45° FOV.
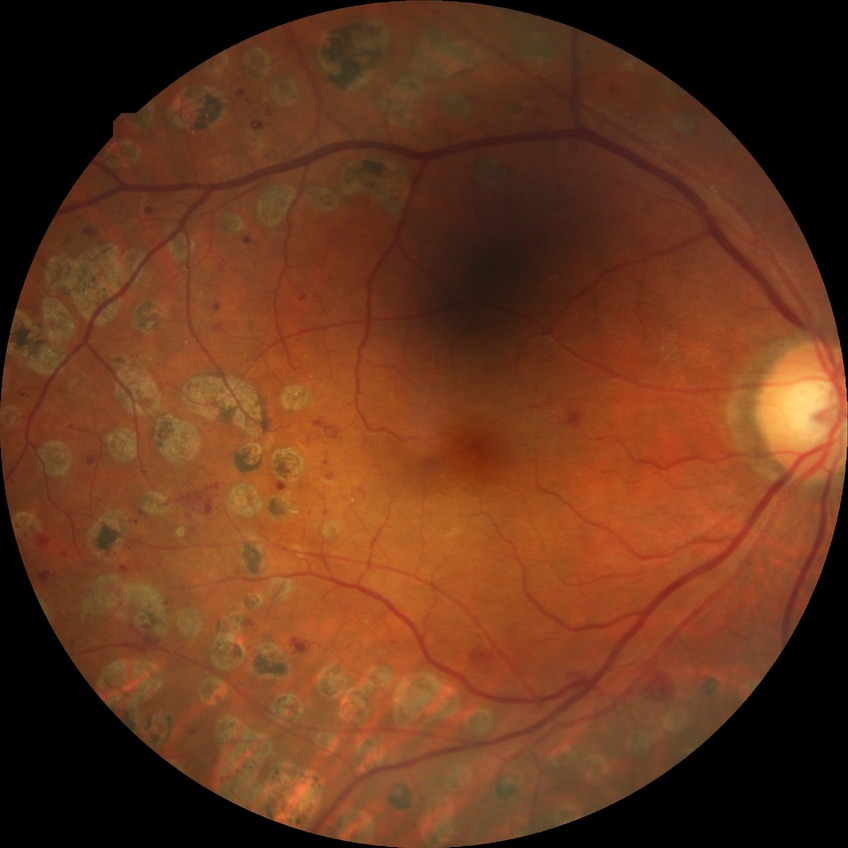
  davis_grade: proliferative diabetic retinopathy